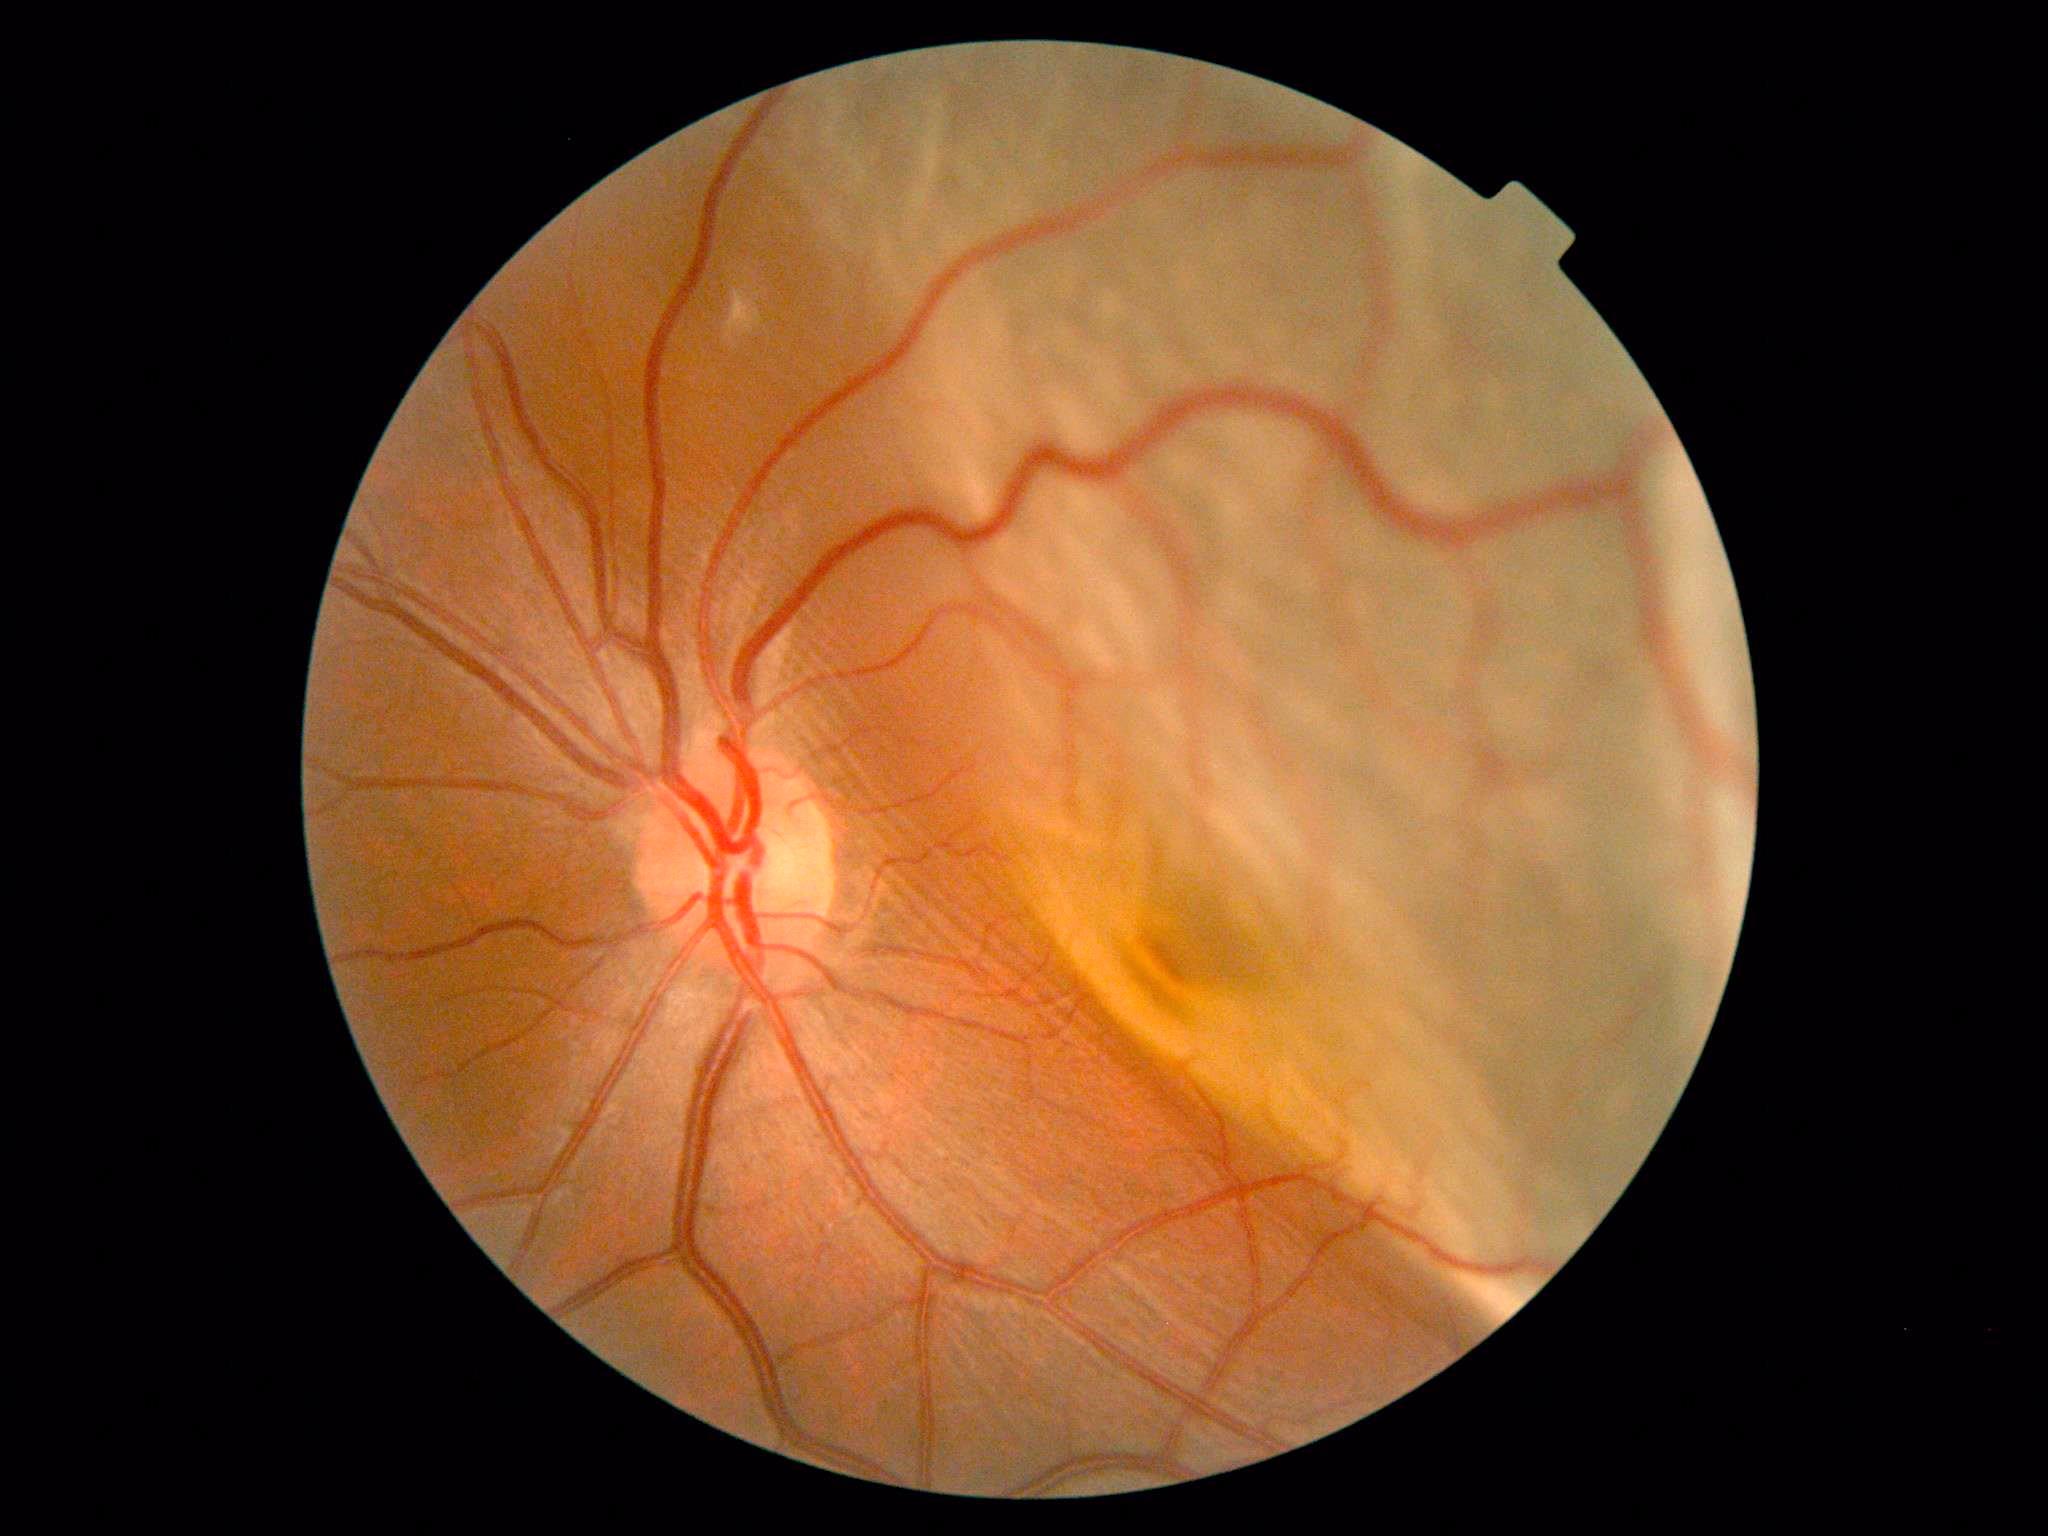

Diabetic retinopathy severity is grade 4 (PDR).